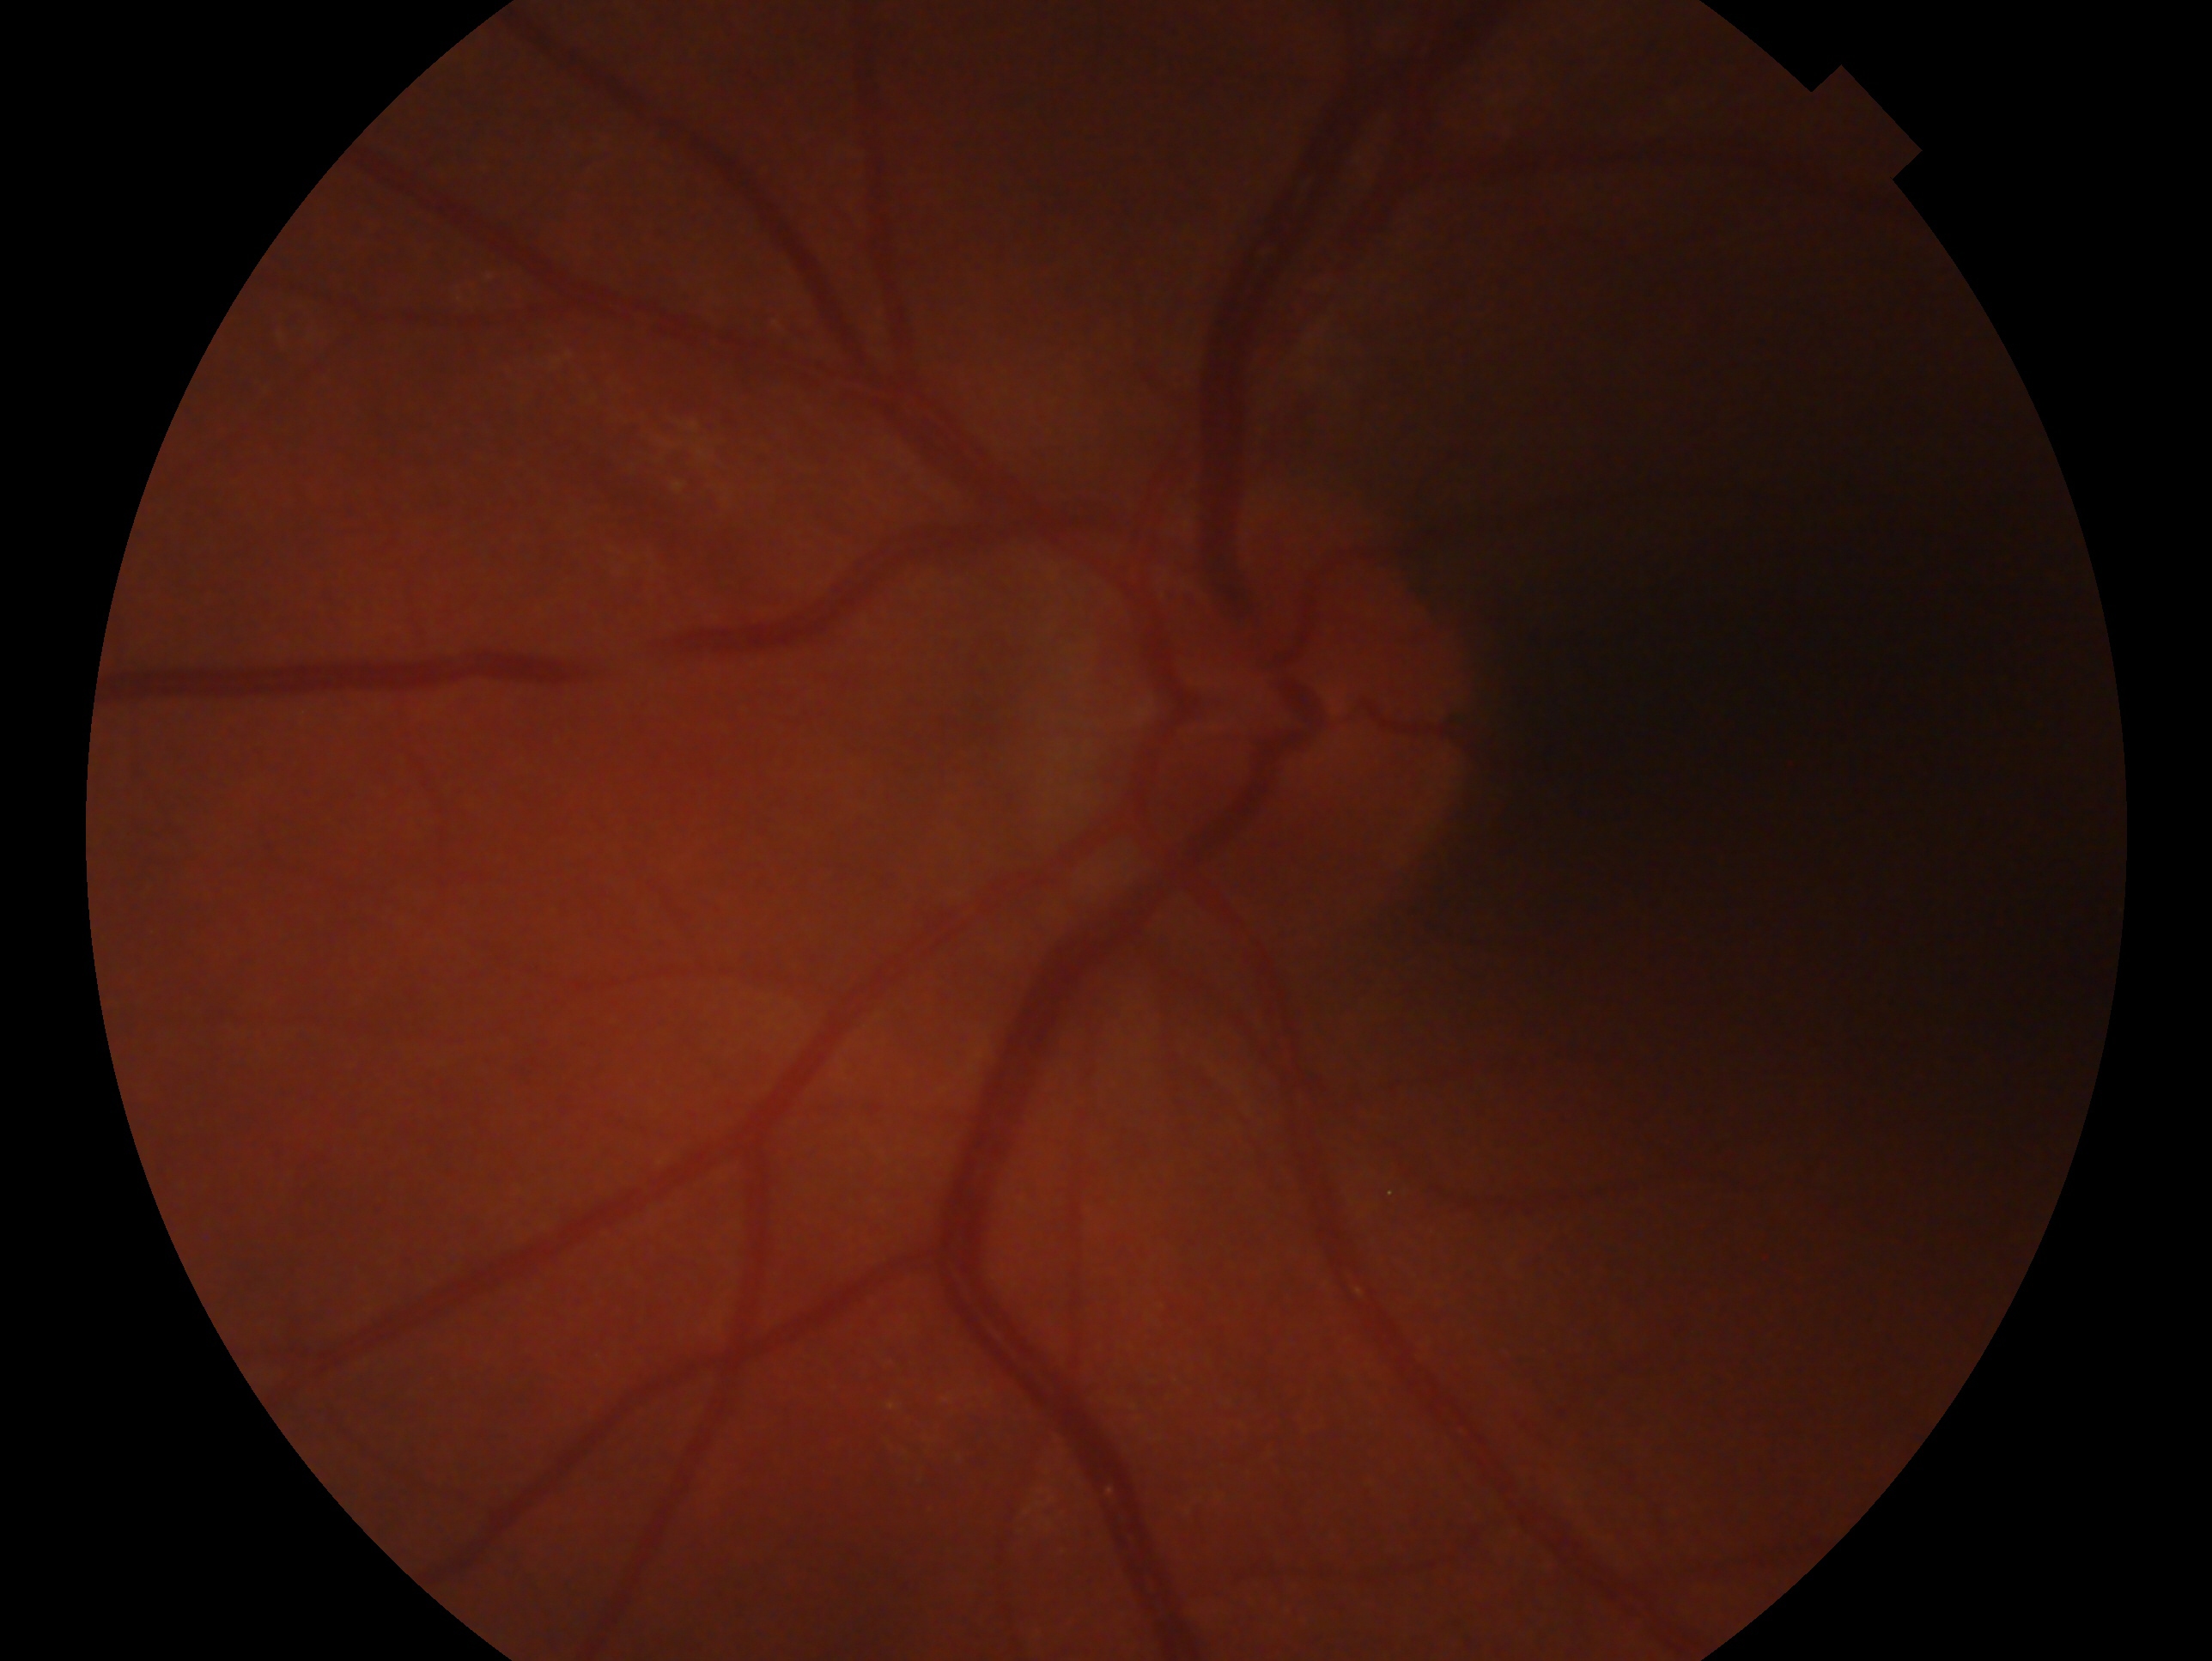

Imaged eye: OS.
Diagnosis: no glaucoma — no clinical evidence of glaucoma in this eye.